NIDEK AFC-230 fundus camera, fundus photo — 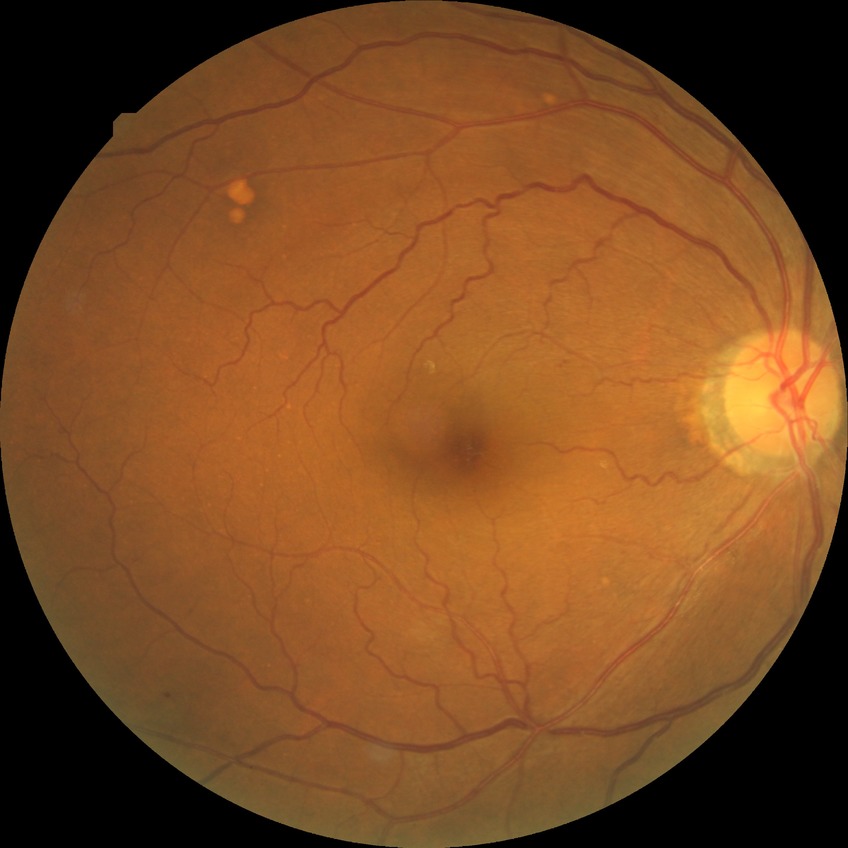

Findings:
* diabetic retinopathy (DR): simple diabetic retinopathy (SDR)